Wide-field fundus photograph of an infant · Clarity RetCam 3, 130° FOV · 640 x 480 pixels: 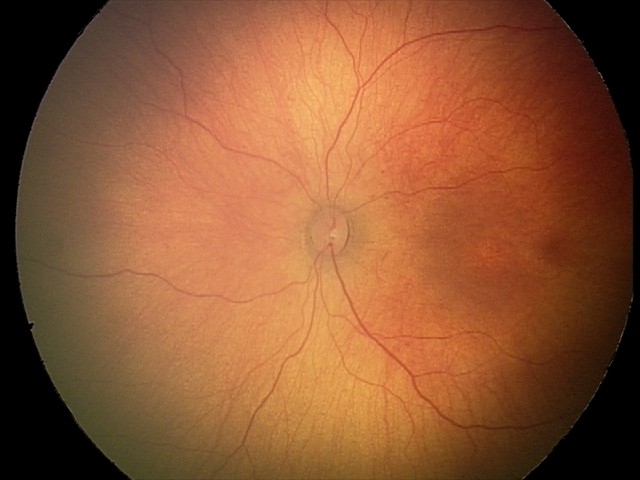 Impression: no abnormal retinal findings.